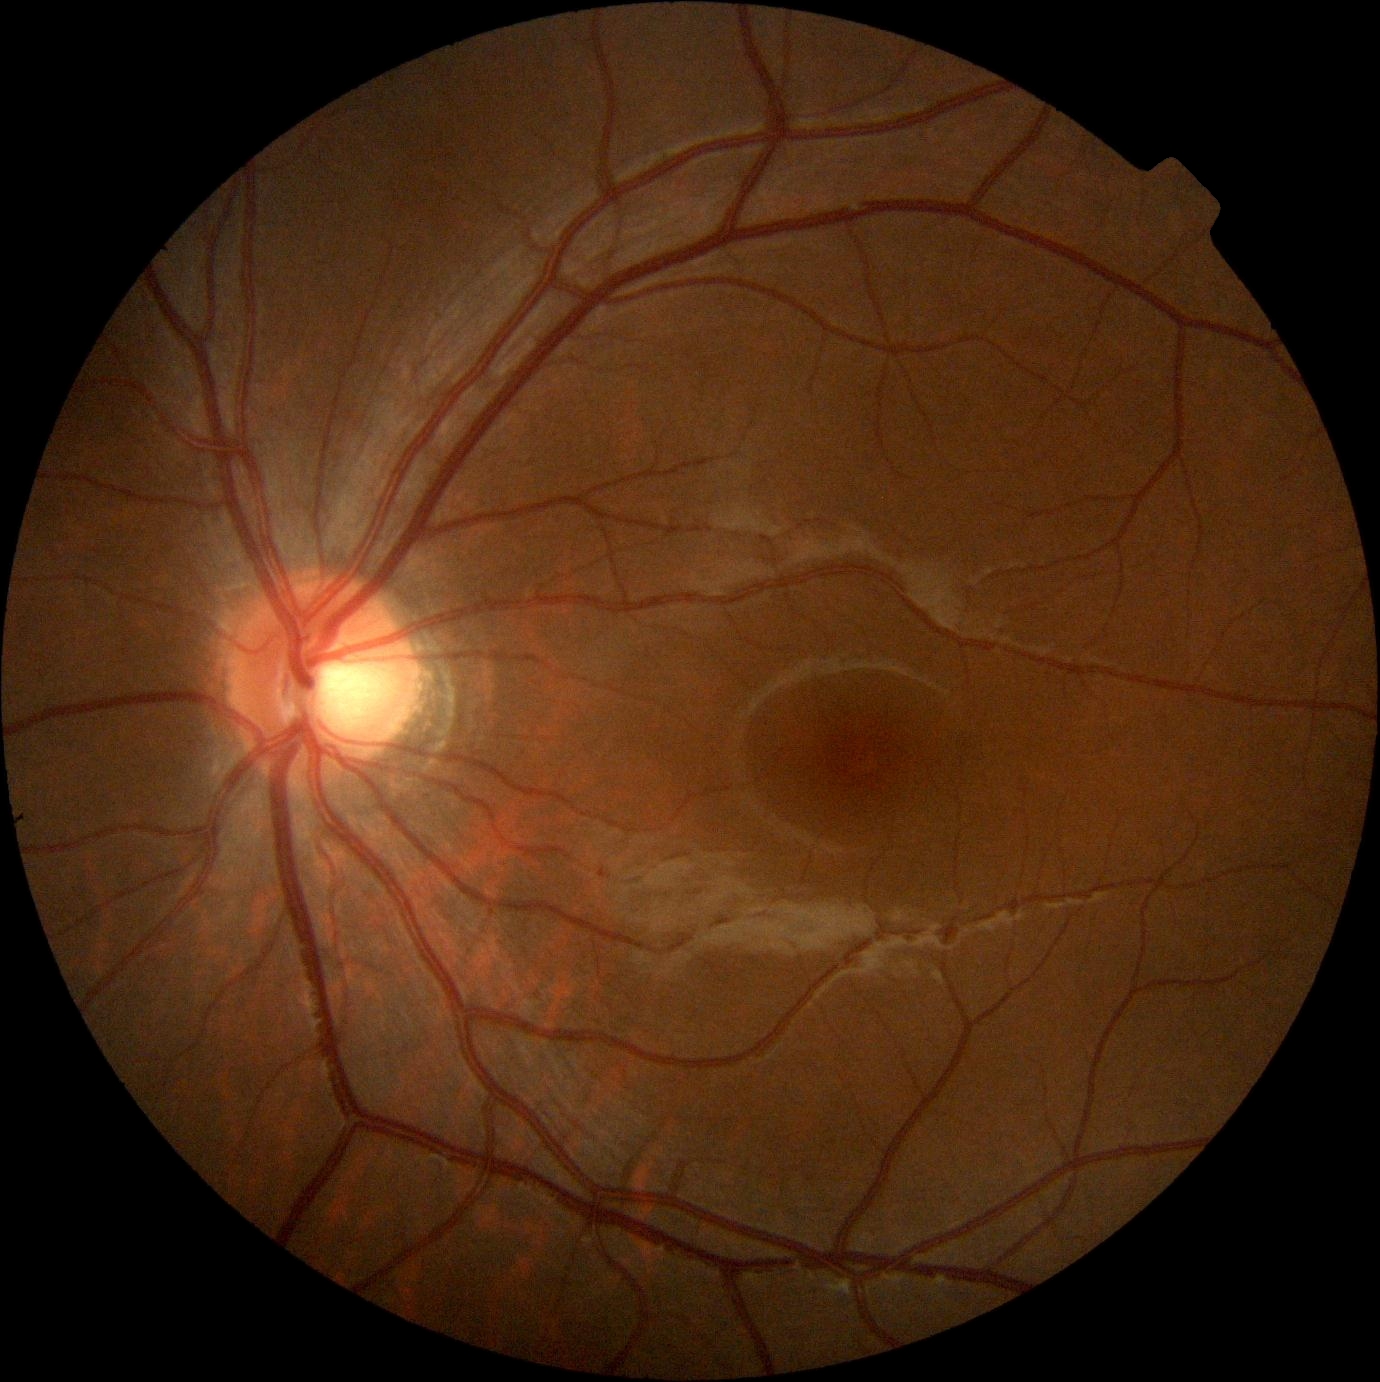

Annotations:
* DR stage: 0
* DR impression: negative for DR